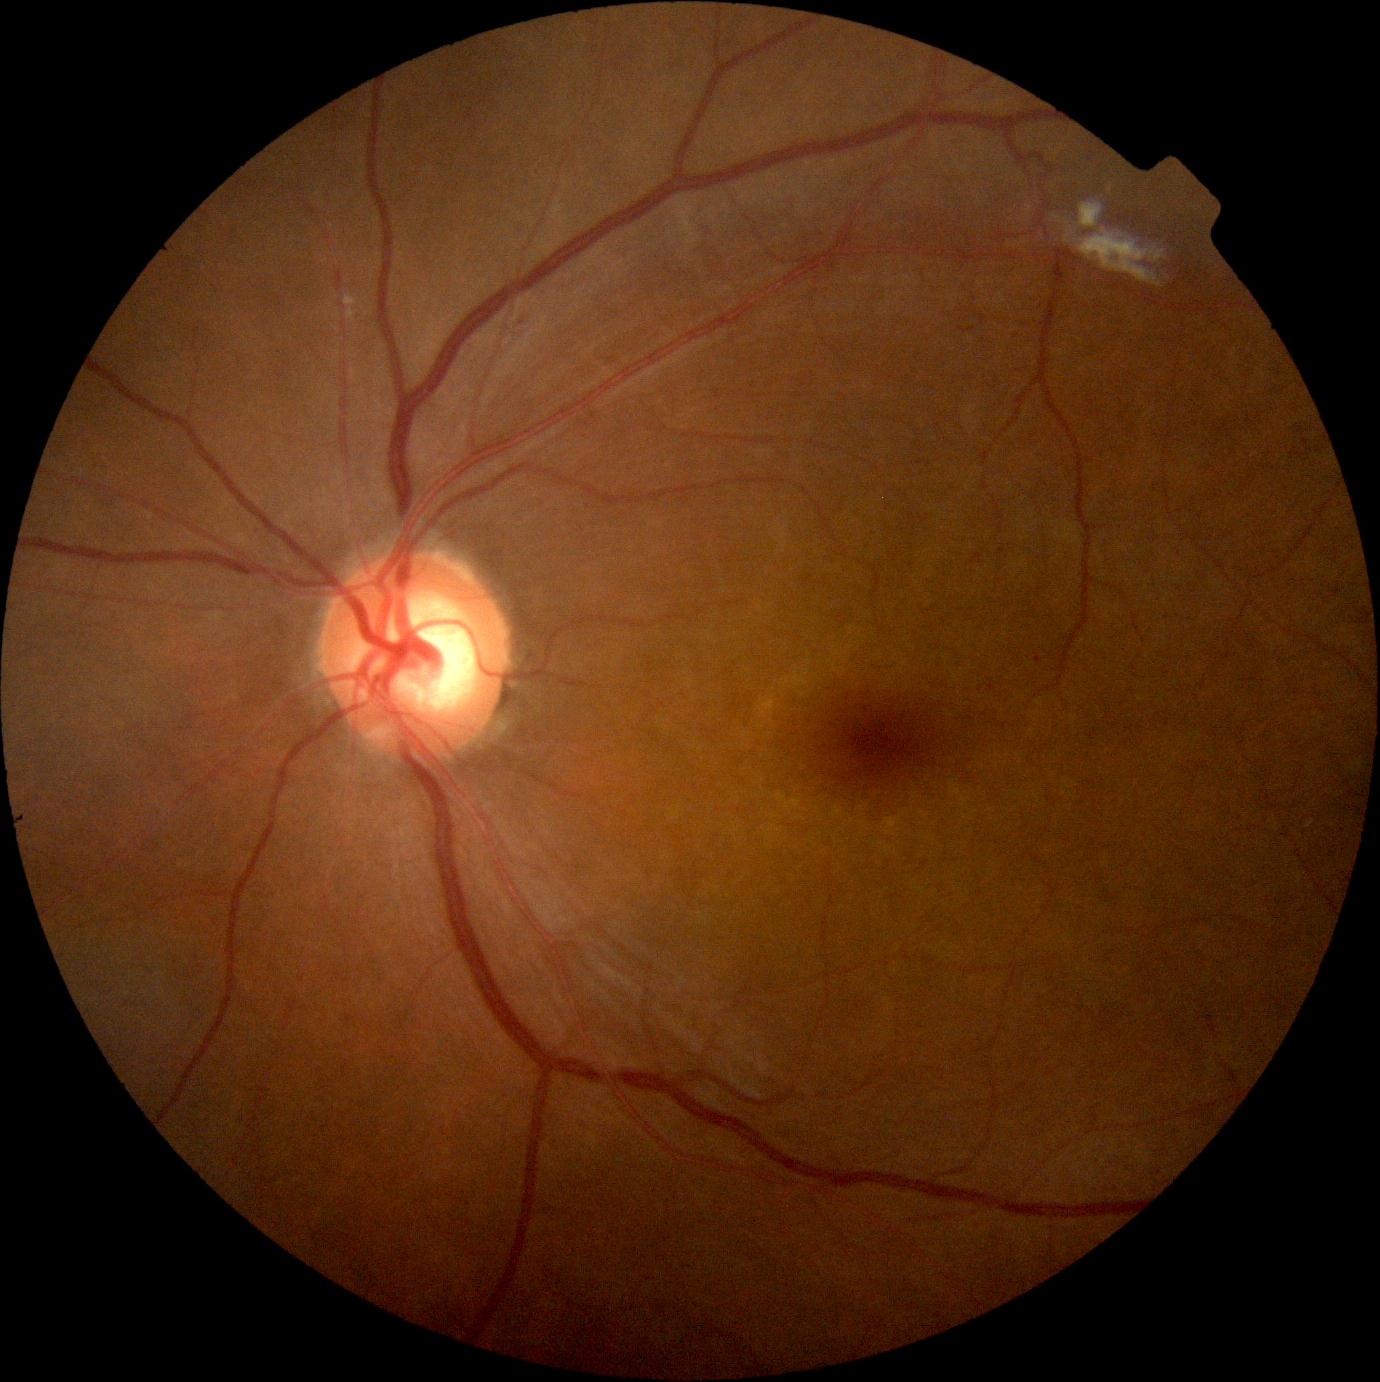

retinopathy@1/4.